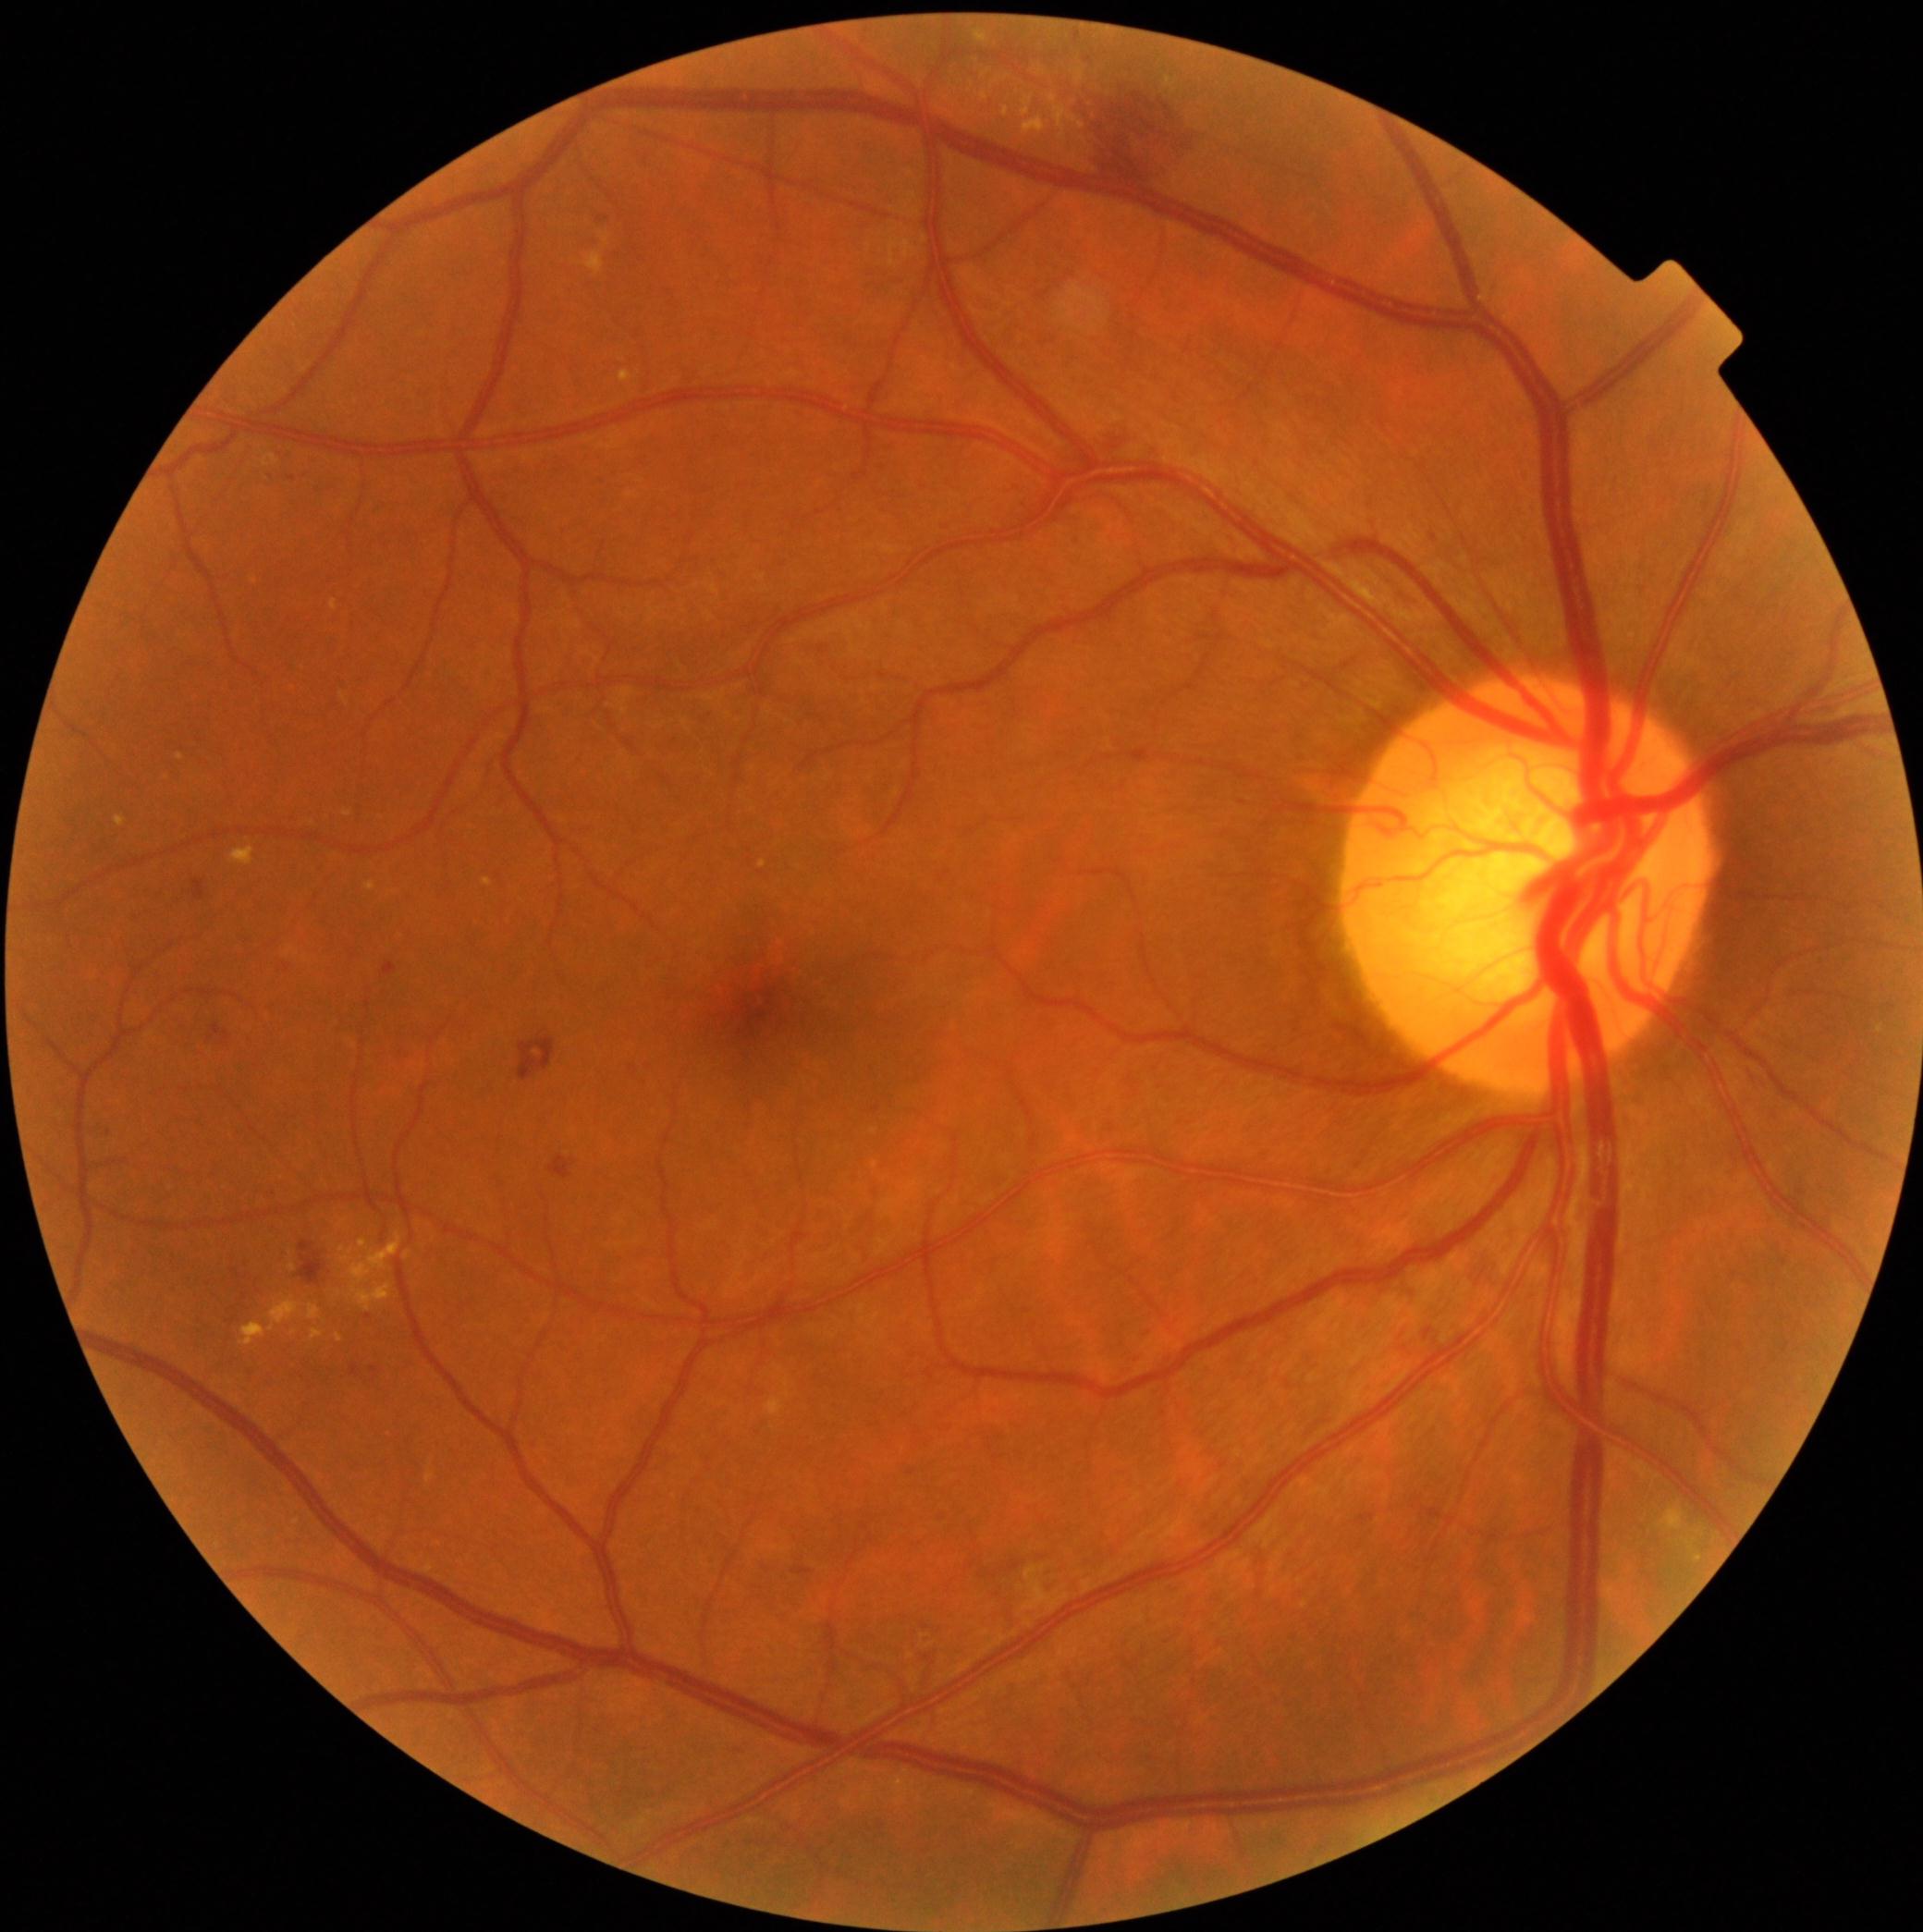 Diabetic retinopathy (DR): grade 2 (moderate NPDR)
Representative lesions:
microaneurysms (MAs) (partial): 370/1367/379/1376 | 351/1365/359/1376 | 1424/1329/1433/1340 | 1013/1566/1021/1571 | 1360/1515/1375/1524 | 213/1026/231/1046
Small MAs approximately at [x=1112, y=1129] | [x=1093, y=1245] | [x=602, y=218] | [x=110, y=1134] | [x=293, y=479]
hemorrhages (HEs) (partial): 383/962/398/977 | 518/1037/556/1082 | 1110/430/1125/459 | 1161/102/1172/119 | 794/1570/811/1575 | 1097/149/1154/194 | 1114/136/1129/149 | 1120/118/1150/140 | 194/882/205/900 | 1110/117/1118/125 | 1146/102/1152/111 | 299/1241/325/1285 | 1112/92/1169/138 | 550/1157/572/1180
Small HEs approximately at [x=1102, y=129]
hard exudates (EXs) (partial): 619/372/634/383 | 342/1234/404/1313 | 404/1251/411/1260 | 766/1399/784/1418 | 366/882/375/893 | 289/1266/297/1271 | 239/1324/267/1346 | 269/1300/300/1333 | 1683/1539/1697/1555 | 331/601/338/612 | 116/818/127/827 | 178/754/185/762
Small EXs approximately at [x=1879, y=1030] | [x=339, y=1295]
soft exudates (SEs): absent